45° field of view.
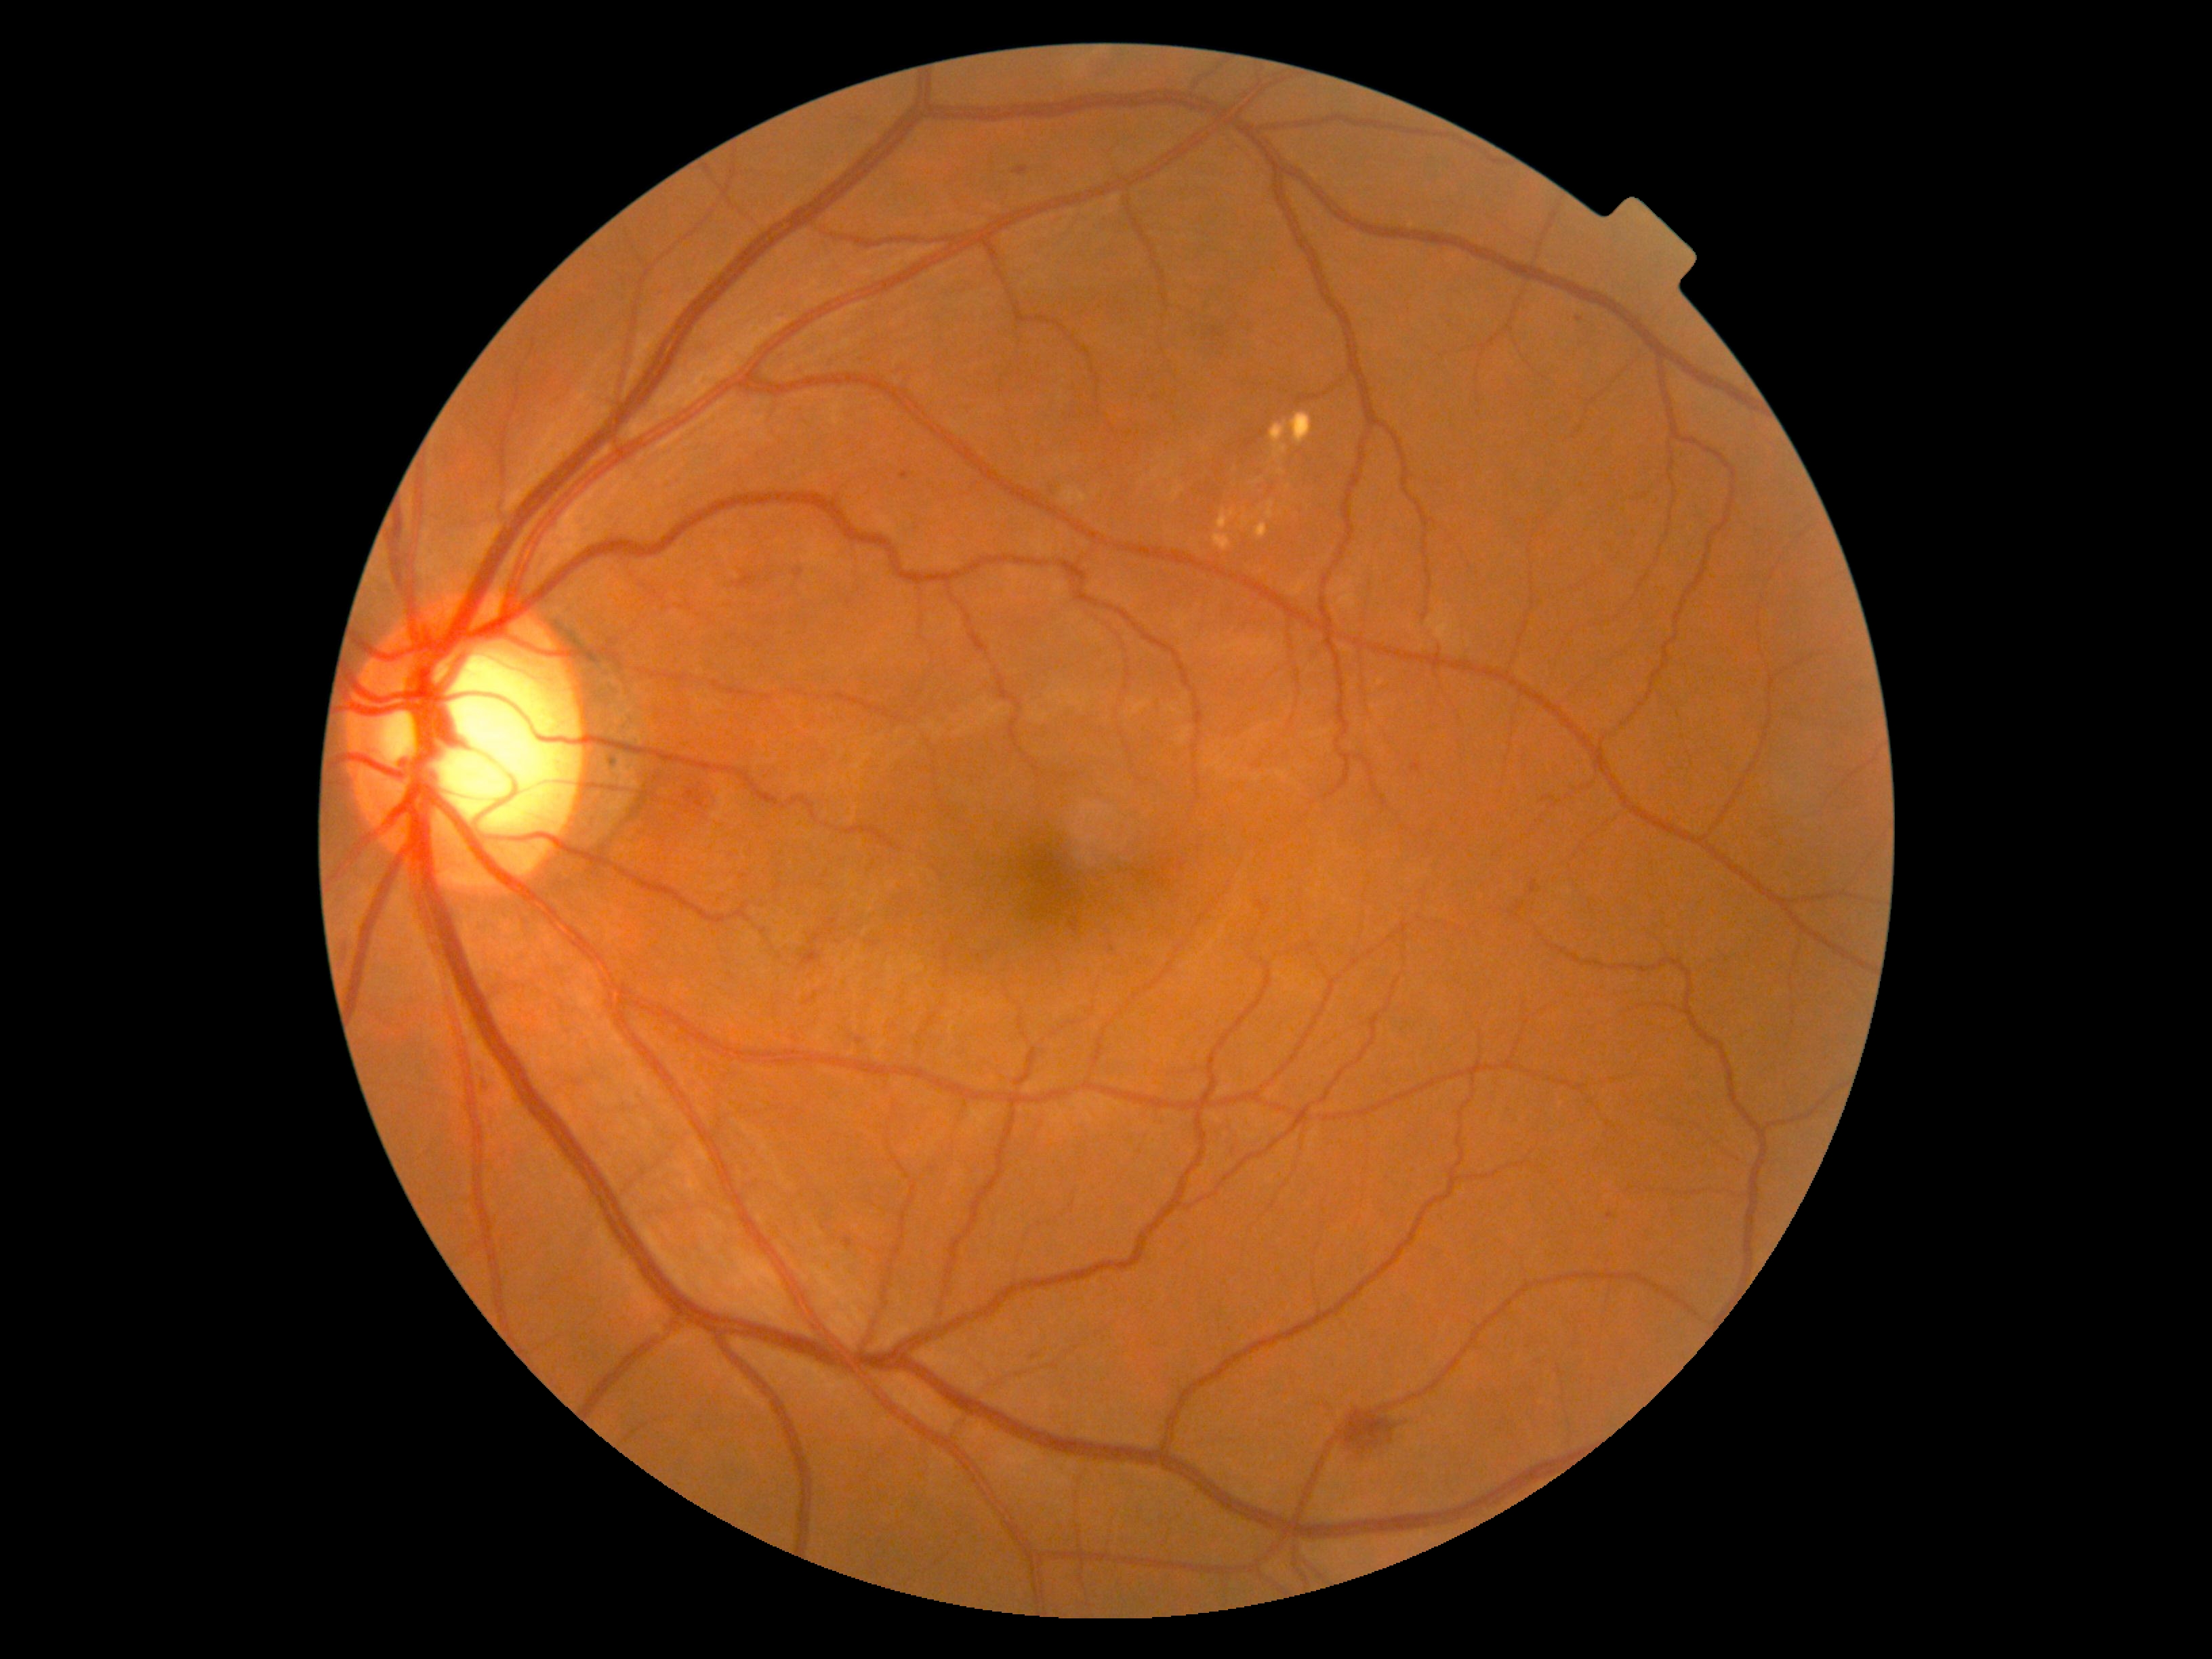
DR stage is 2/4; non-proliferative diabetic retinopathy
SEs = none detected
EXs = 1267/501/1275/520; 1269/411/1313/459; 1256/523/1268/540; 1277/468/1286/475; 1212/533/1231/552; 1218/510/1235/529
Small EXs near [x=1235, y=469]; [x=1289, y=487]
MAs = 794/569/803/577; 480/1069/486/1085; 845/1237/852/1246; 1047/483/1062/494; 1031/1352/1040/1359; 1530/880/1538/894; 1071/922/1078/932; 1015/167/1028/176; 1412/761/1422/772; 901/472/909/479; 802/949/822/964
Small MAs near [x=1579, y=320]; [x=1113, y=949]; [x=1610, y=1215]
HEs = 1337/1408/1398/1451; 688/794/718/817